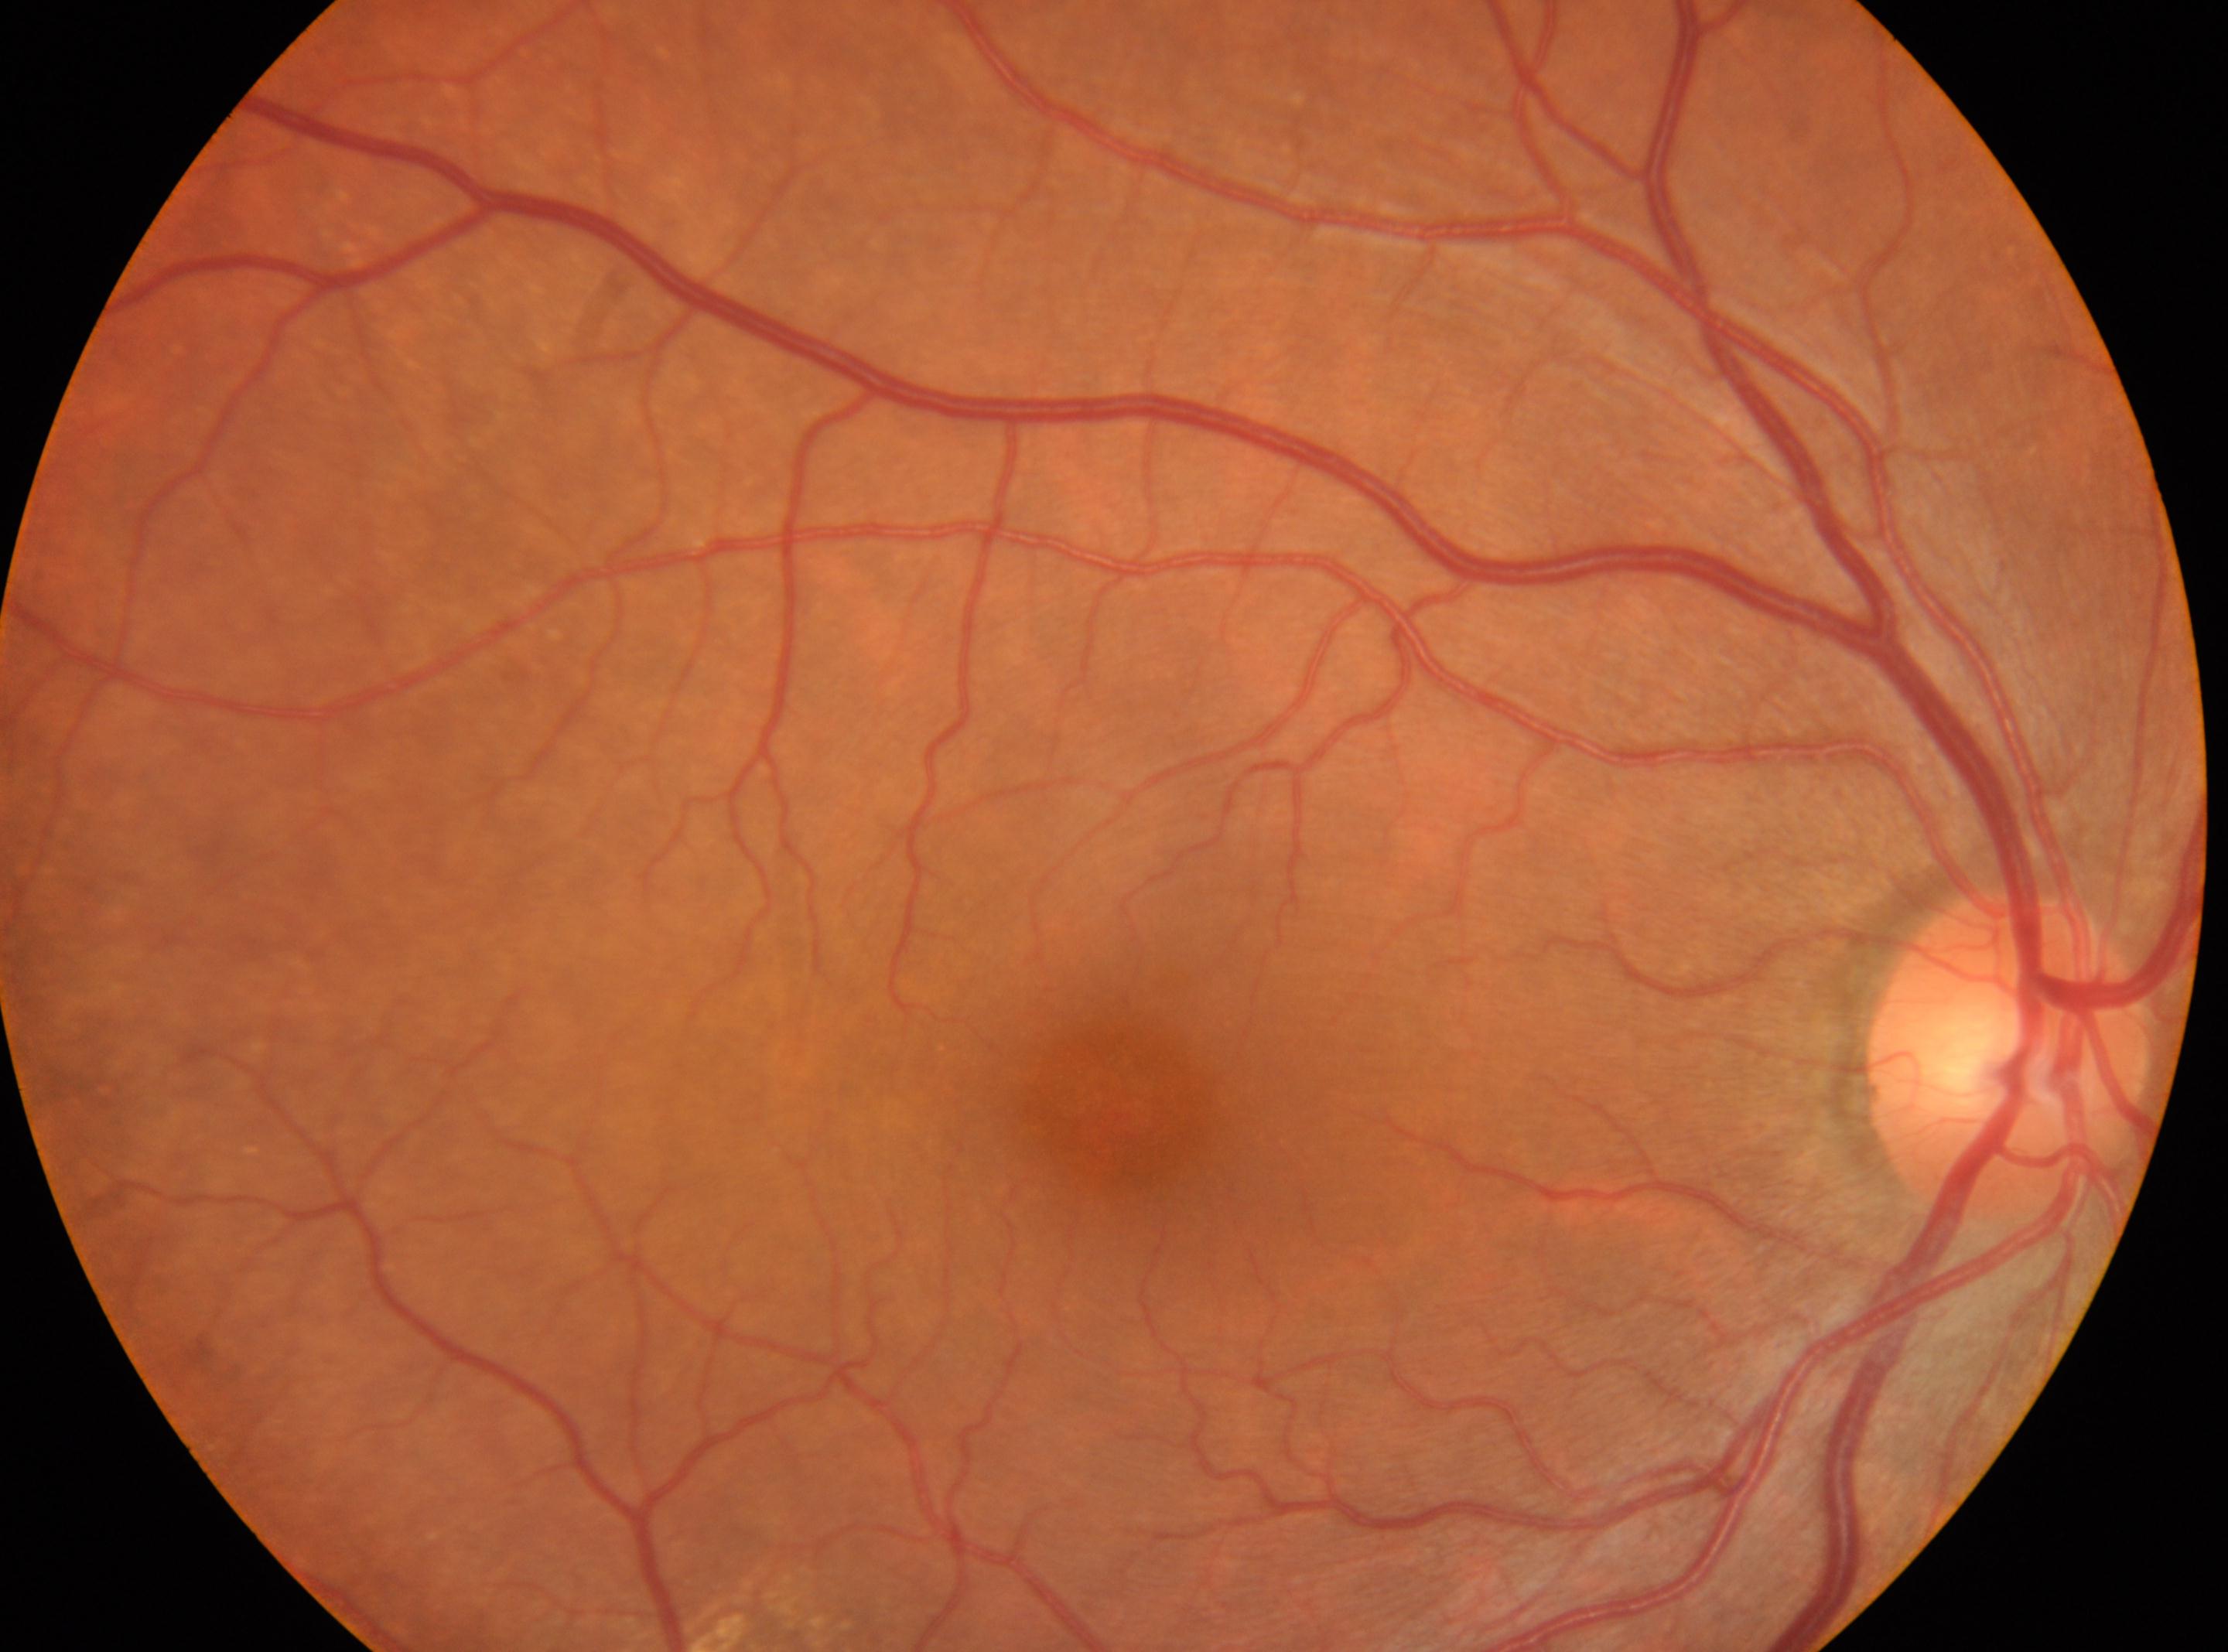
No diabetic retinal disease findings. Fovea centralis located at (x: 1122, y: 1114). Eye: right. ONH: (x: 2010, y: 1052). Diabetic retinopathy severity: no apparent retinopathy (grade 0).